2228x1652; posterior pole field covering the optic disc and macula.
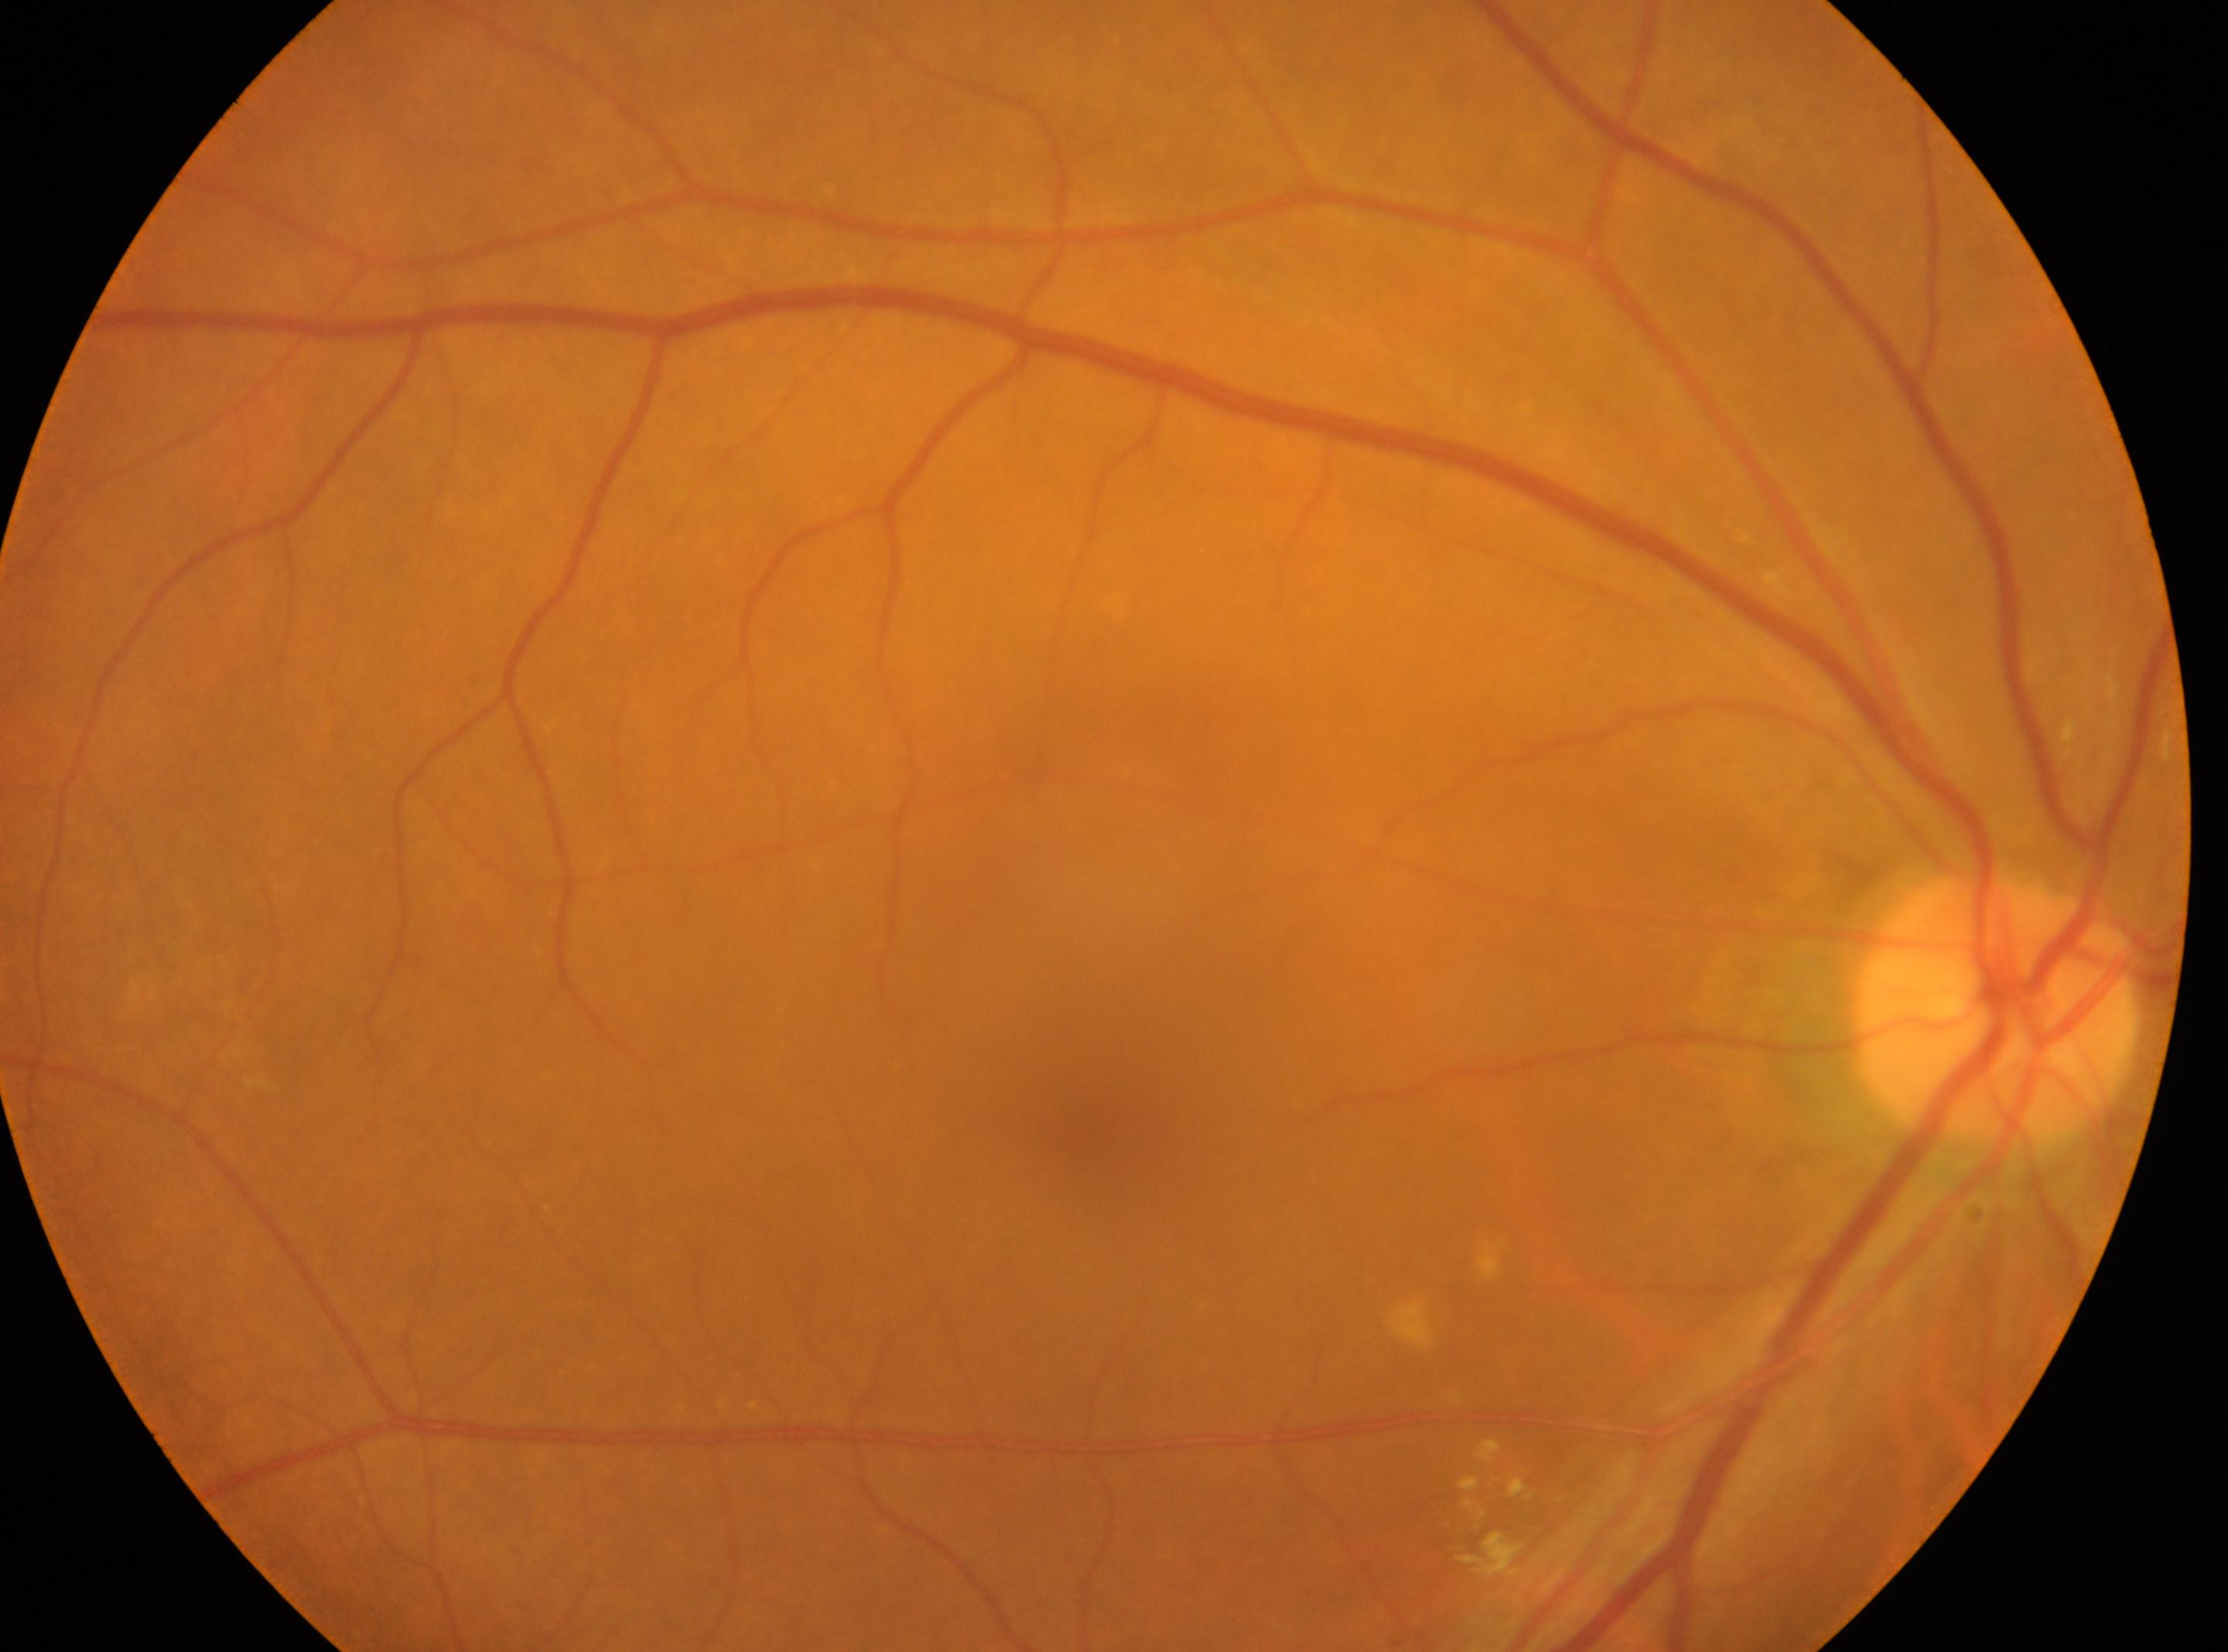 The fovea is at 1083px, 1128px.
Optic disc: 1995px, 1007px.
DR severity is 2/4.
This is the oculus dexter.